Graded on the modified Davis scale · acquired with a NIDEK AFC-230:
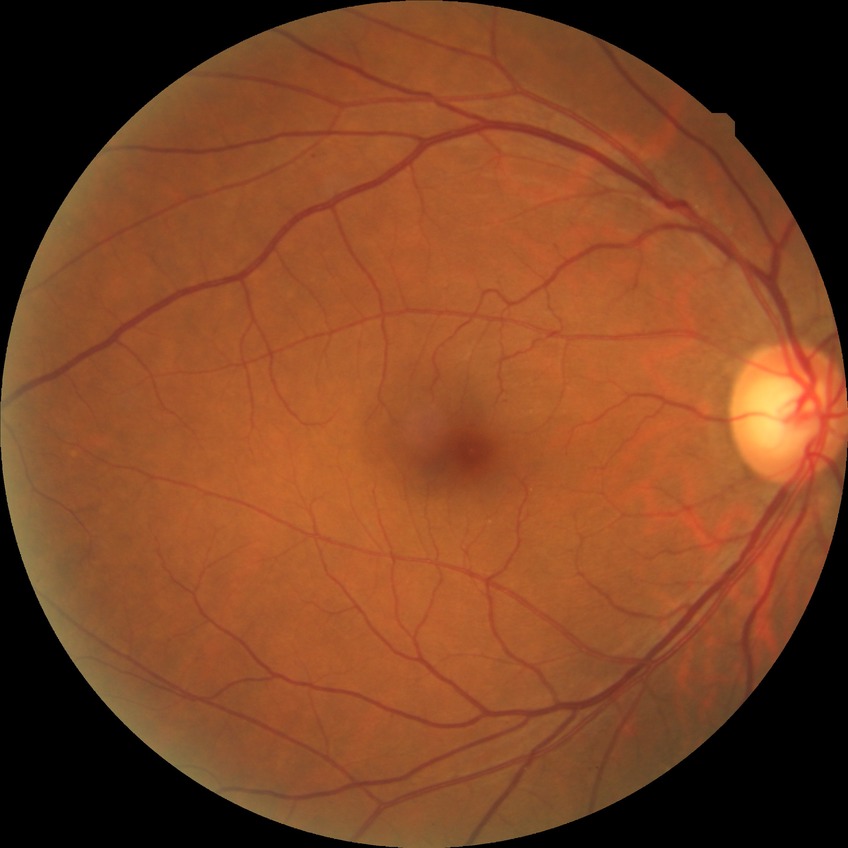
Diabetic retinopathy (DR): NDR (no diabetic retinopathy).